Retinal fundus photograph · 45° field of view.
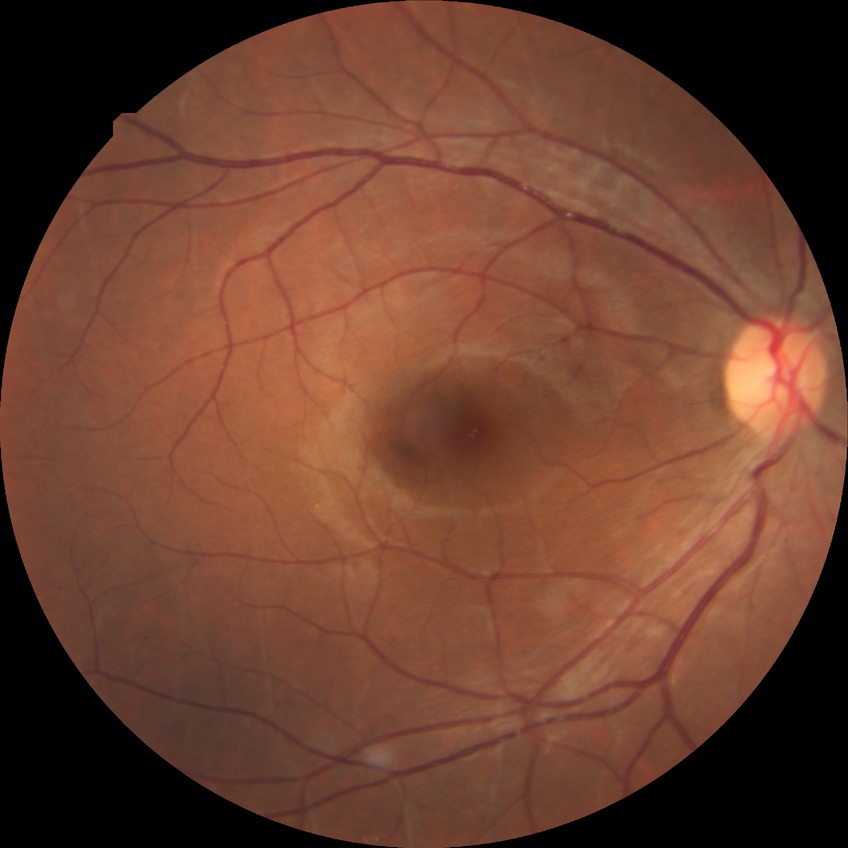 {
  "davis_grade": "no diabetic retinopathy (NDR)"
}